Fundus photo, 45° field of view, image size 2352x1568:
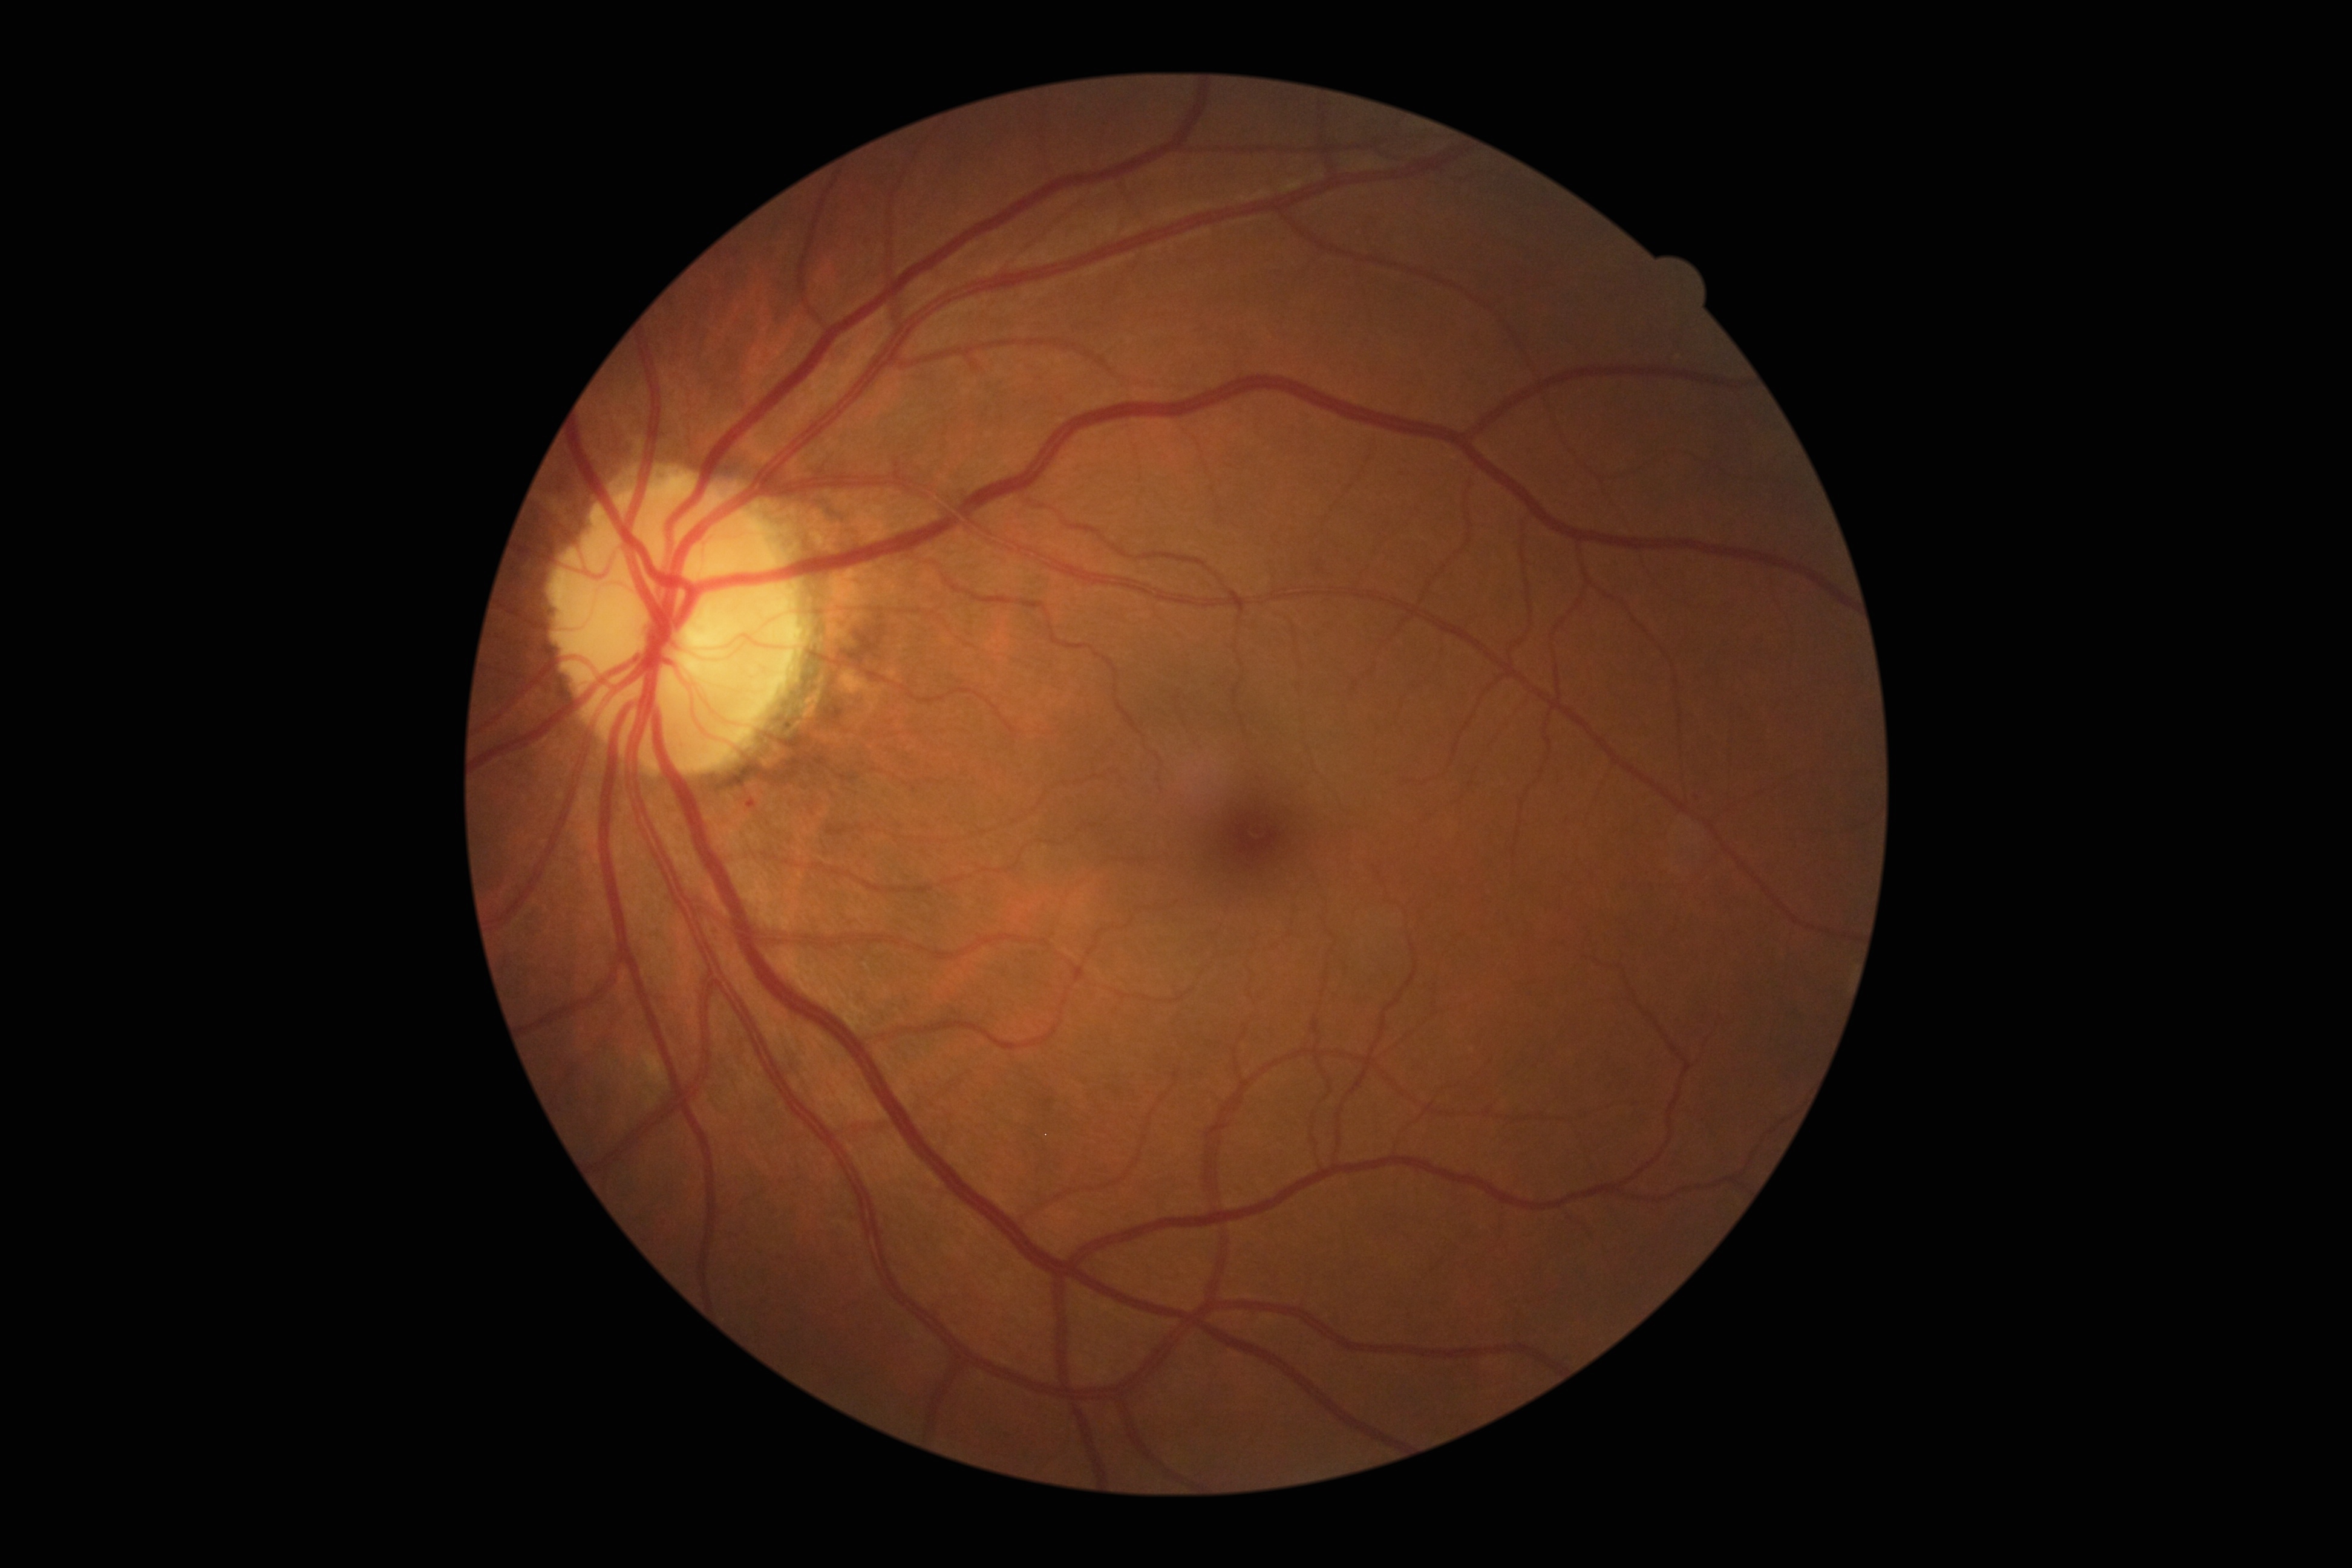

Diabetic retinopathy (DR) is grade 2 (moderate NPDR).